1240 by 1240 pixels; wide-field fundus image from infant ROP screening; Phoenix ICON, 100° FOV:
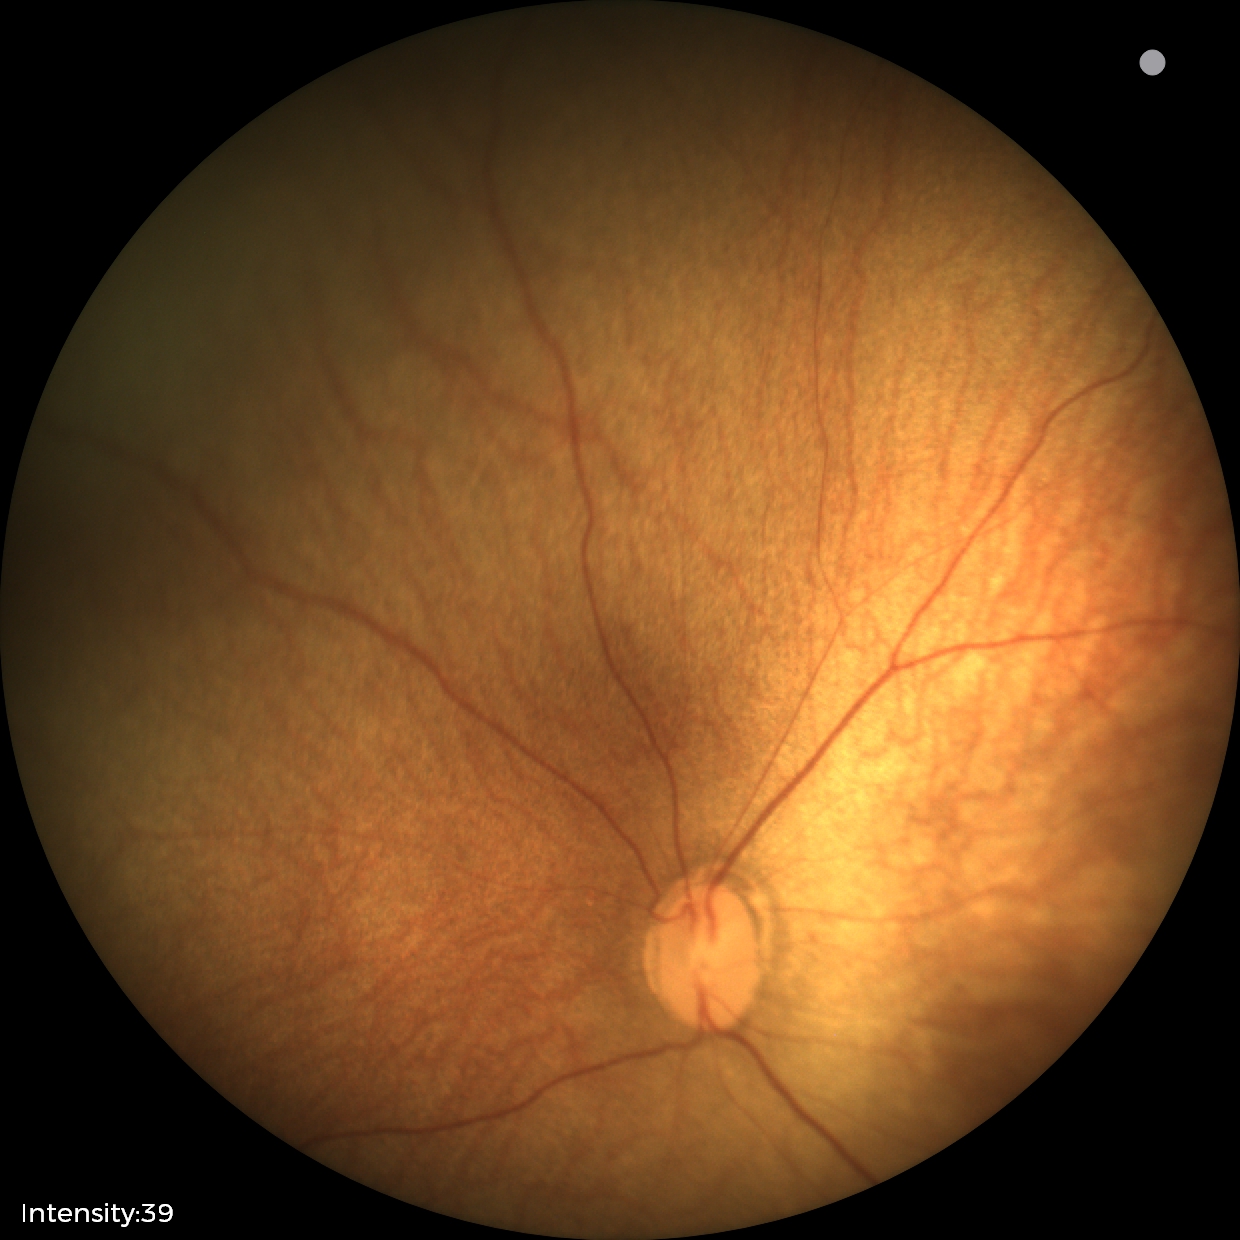 Screening diagnosis: physiological appearance with no retinal pathology.